Camera: NIDEK AFC-230; nonmydriatic.
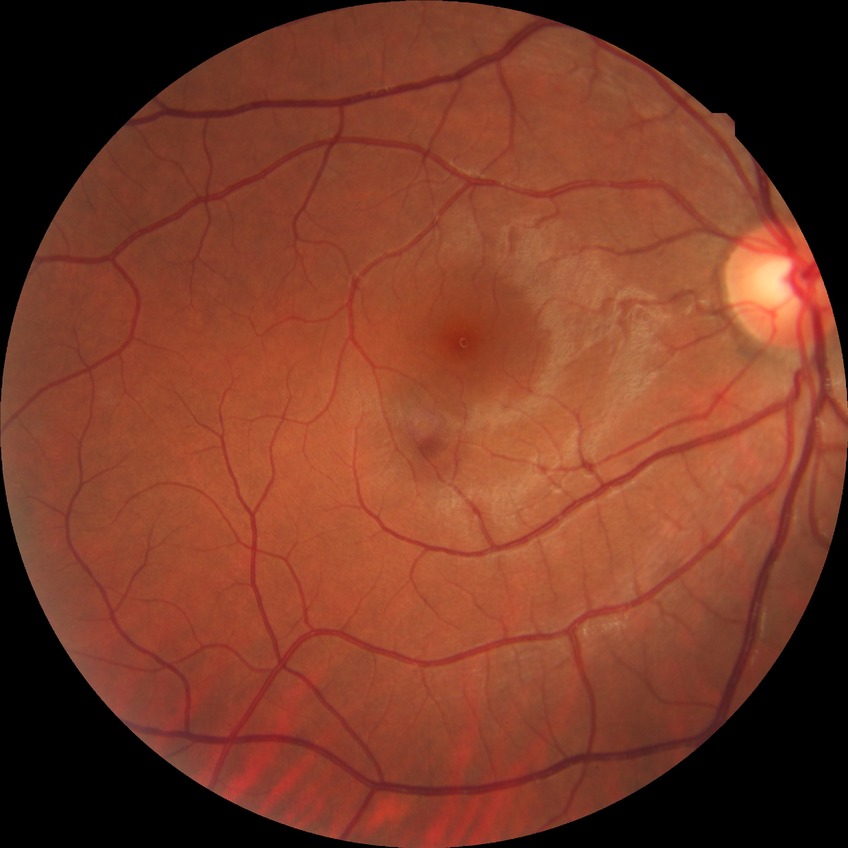 Diabetic retinopathy (DR) is no diabetic retinopathy (NDR).